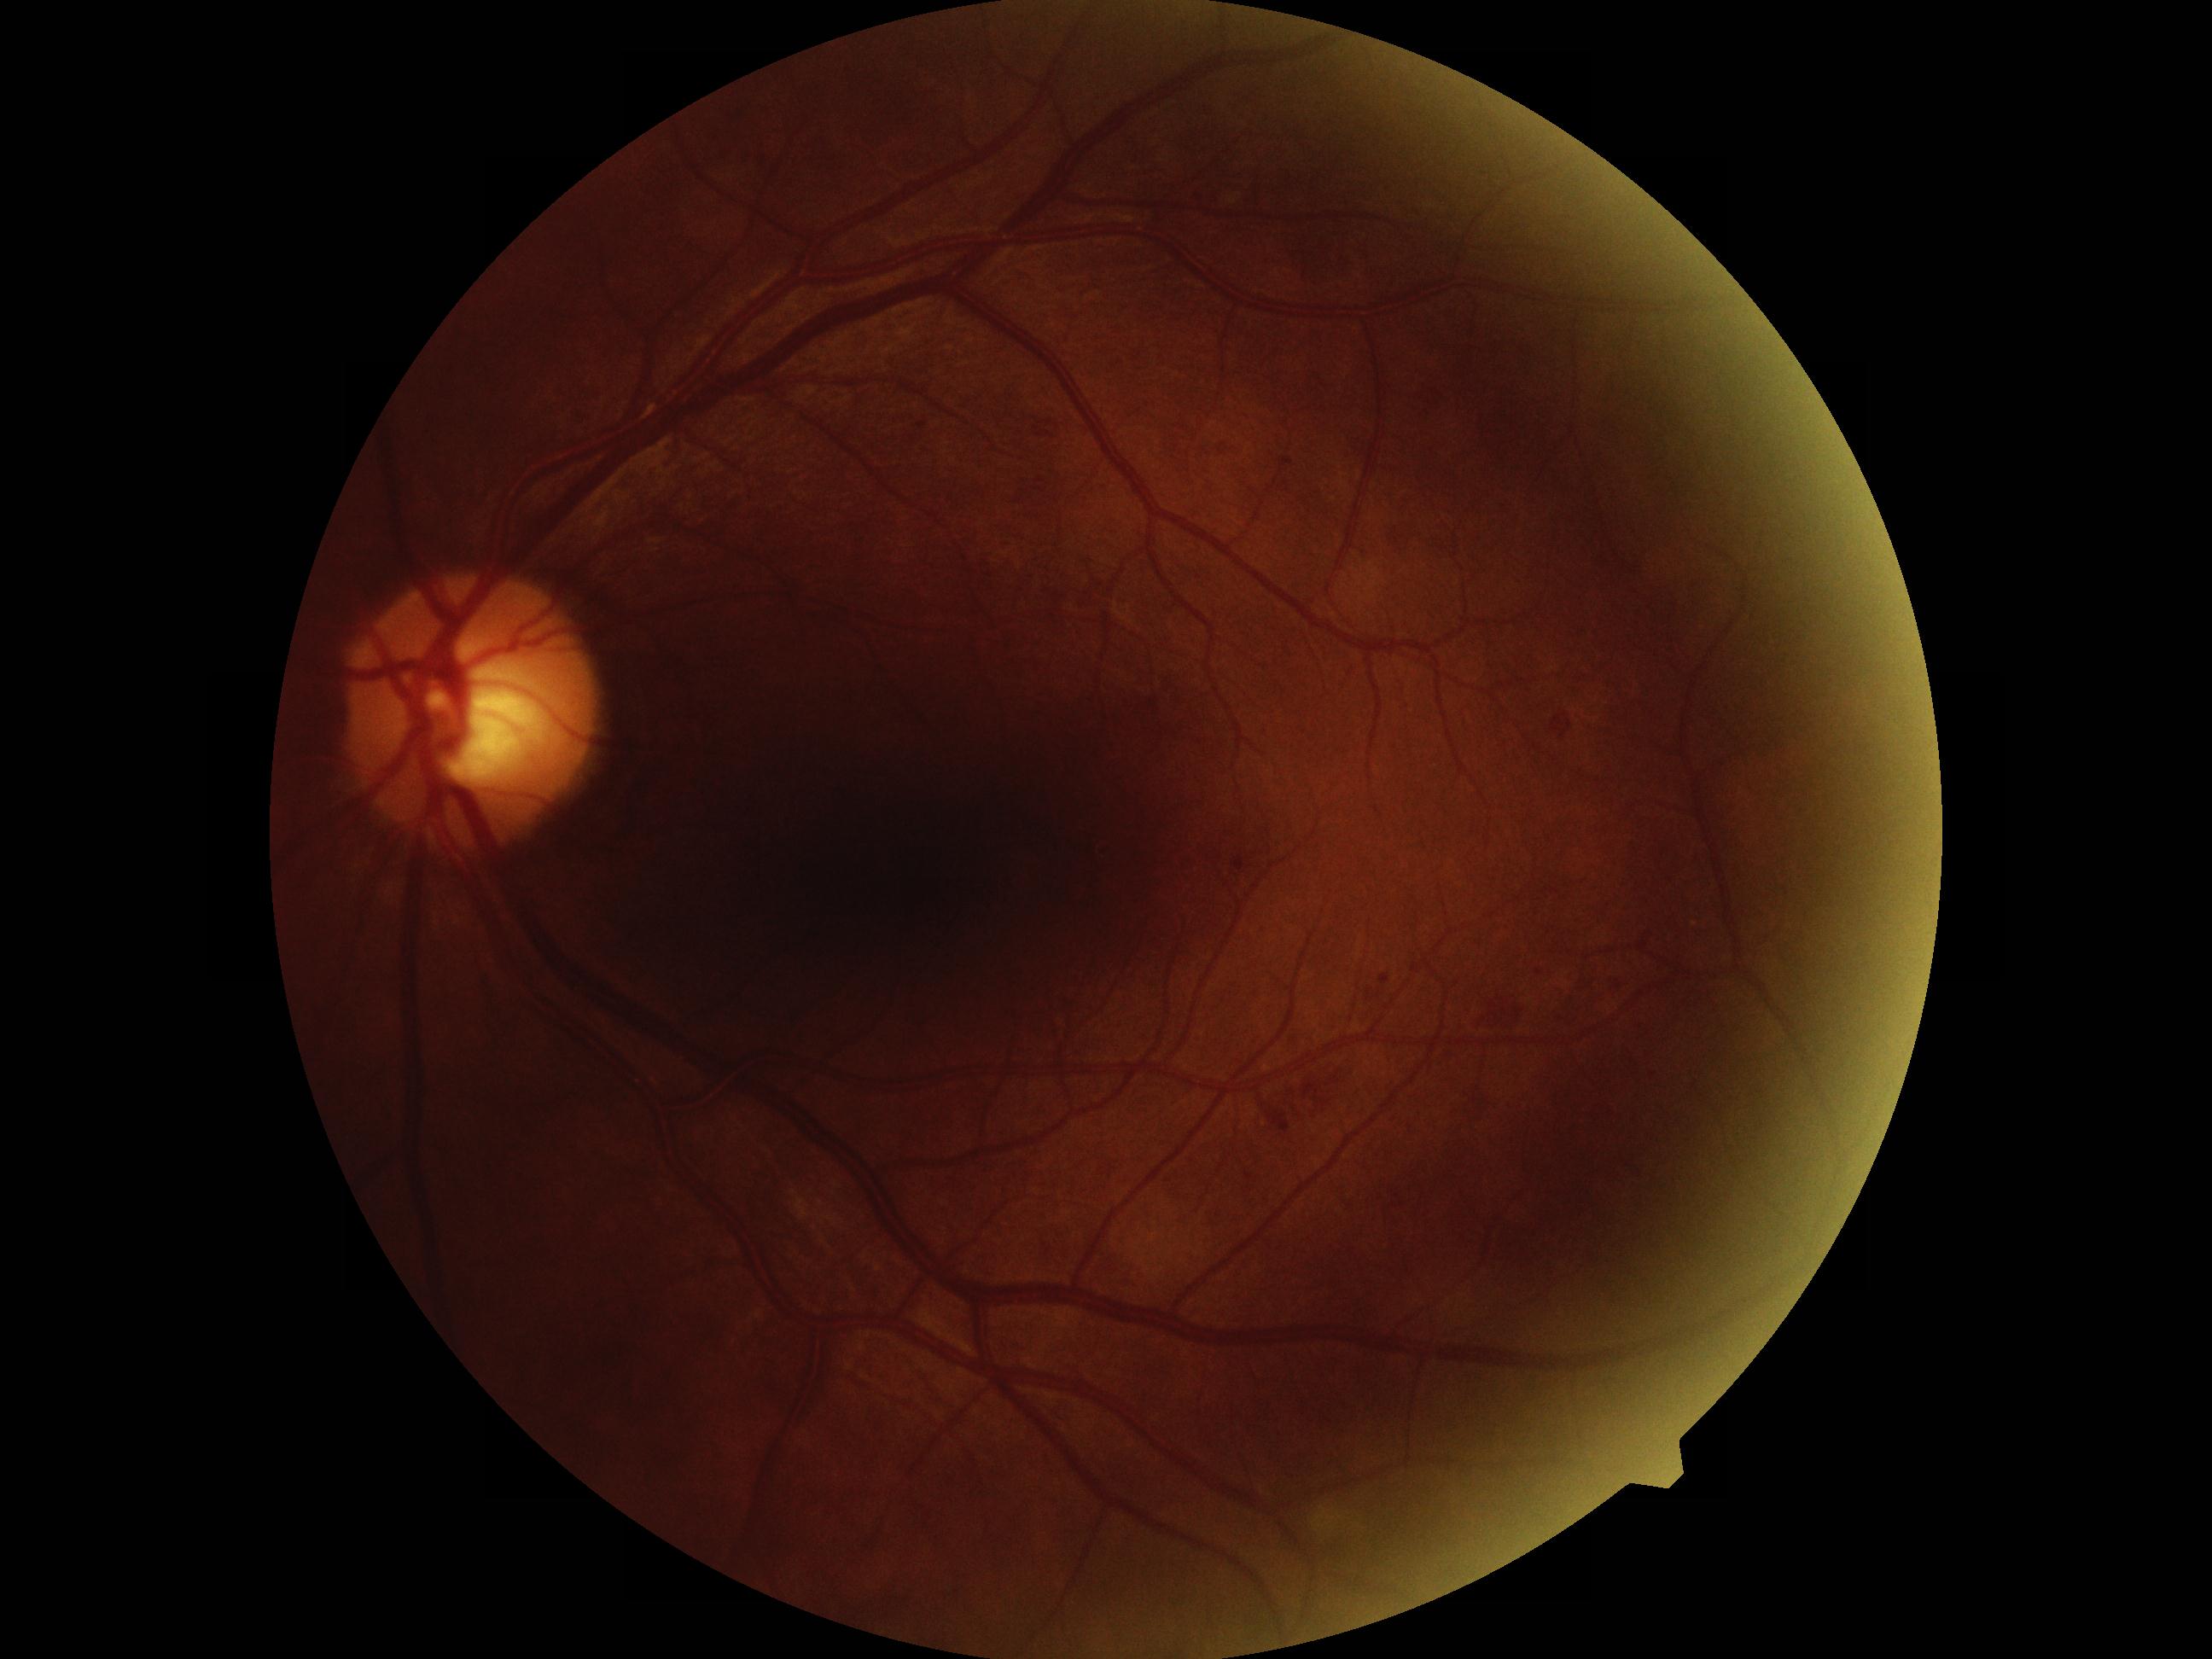

retinopathy = grade 2 (moderate NPDR) — more than just microaneurysms but less than severe NPDR.